Topcon TRC-50DX:
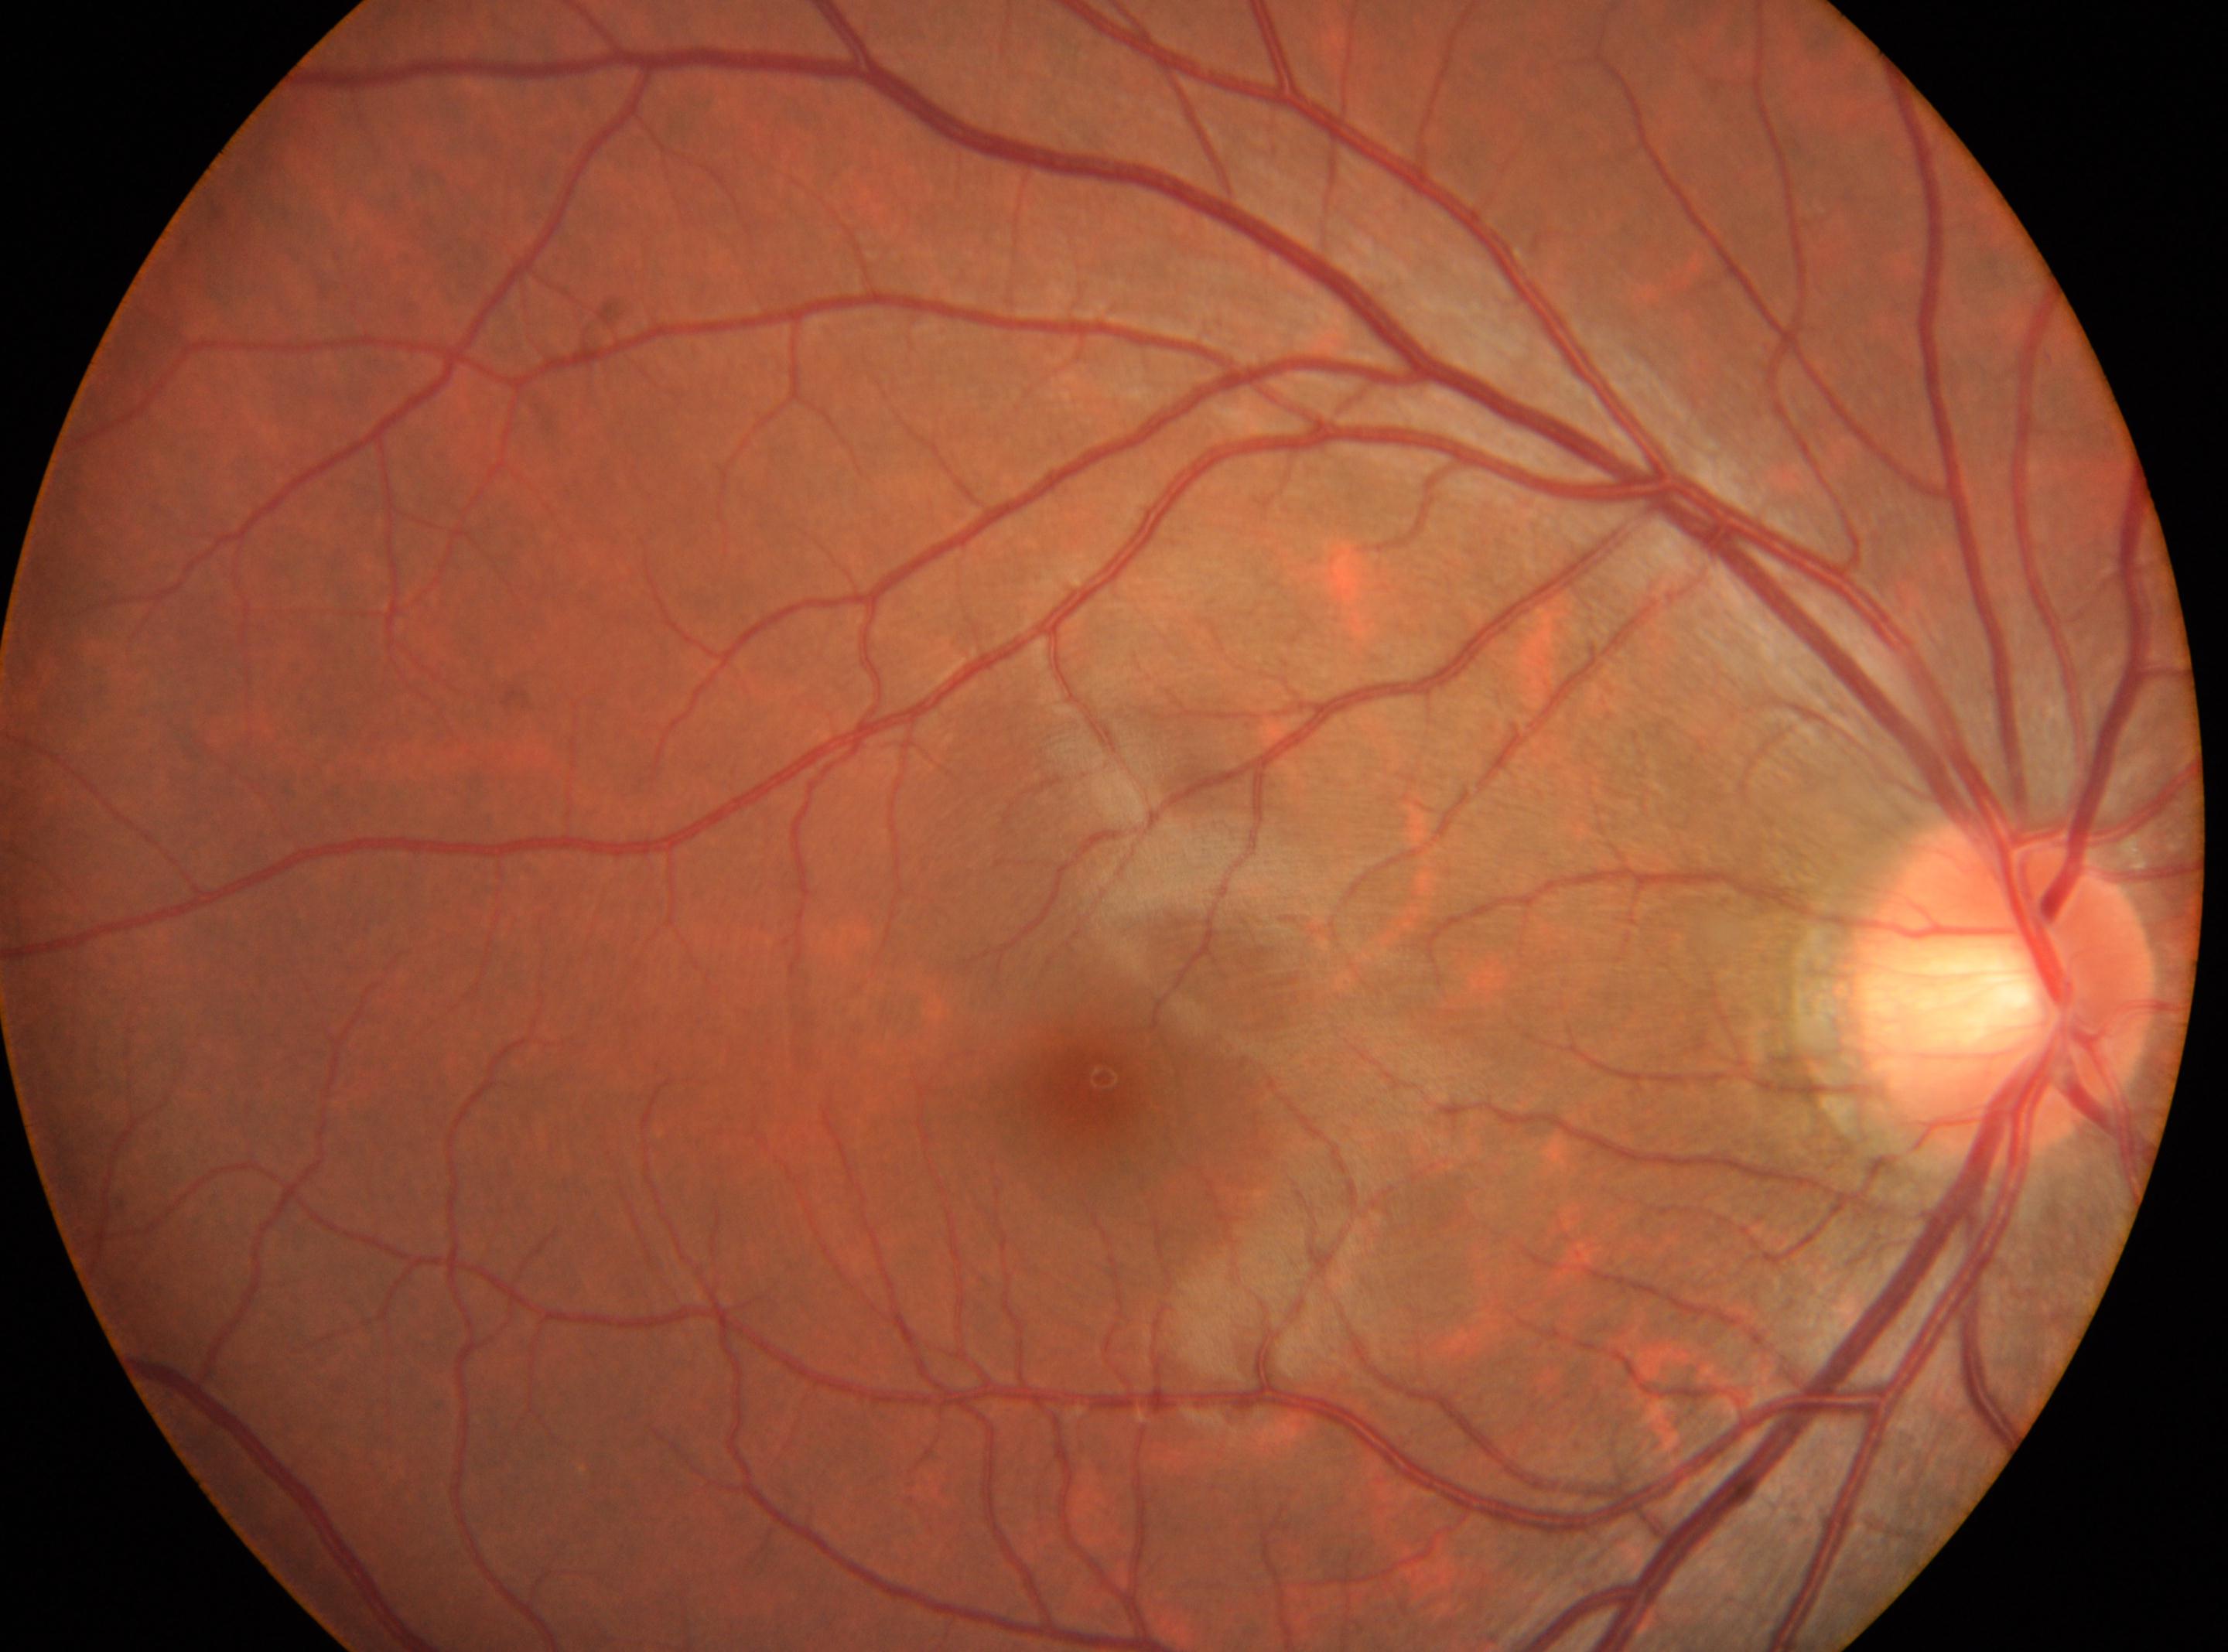 ONH: (2005, 987).
DR: 0.
Eye: OD.
Fovea located at (1094, 1086).